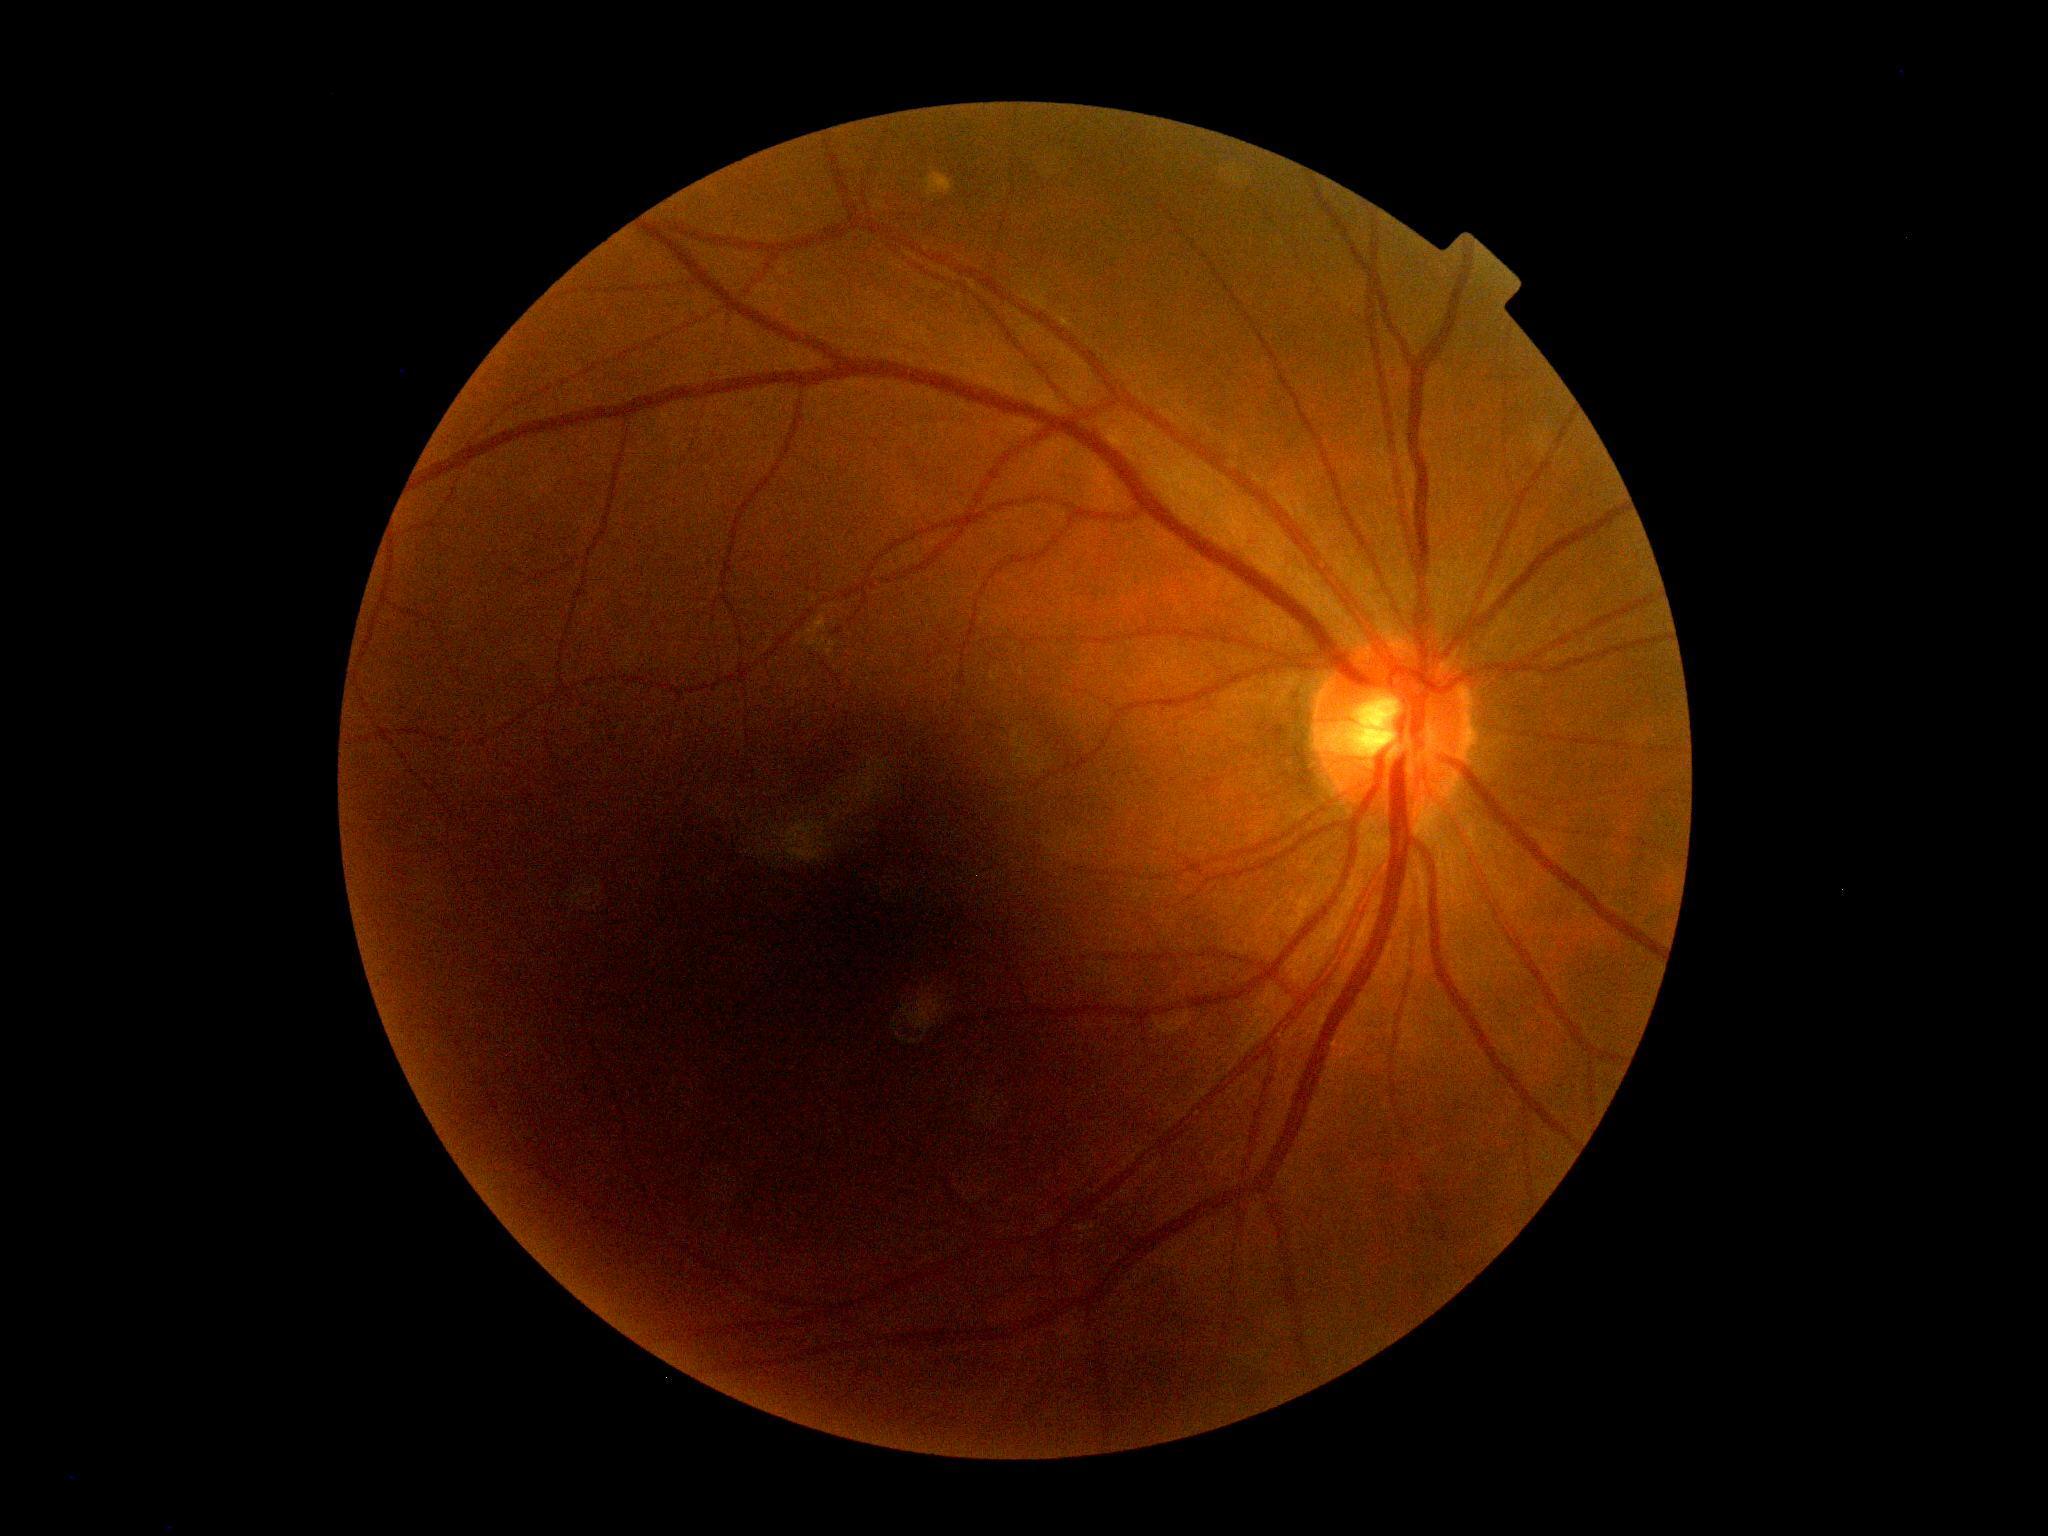
No DR findings. Diabetic retinopathy severity is 0/4 — no visible signs of diabetic retinopathy.